45-degree field of view, DR severity per modified Davis staging: 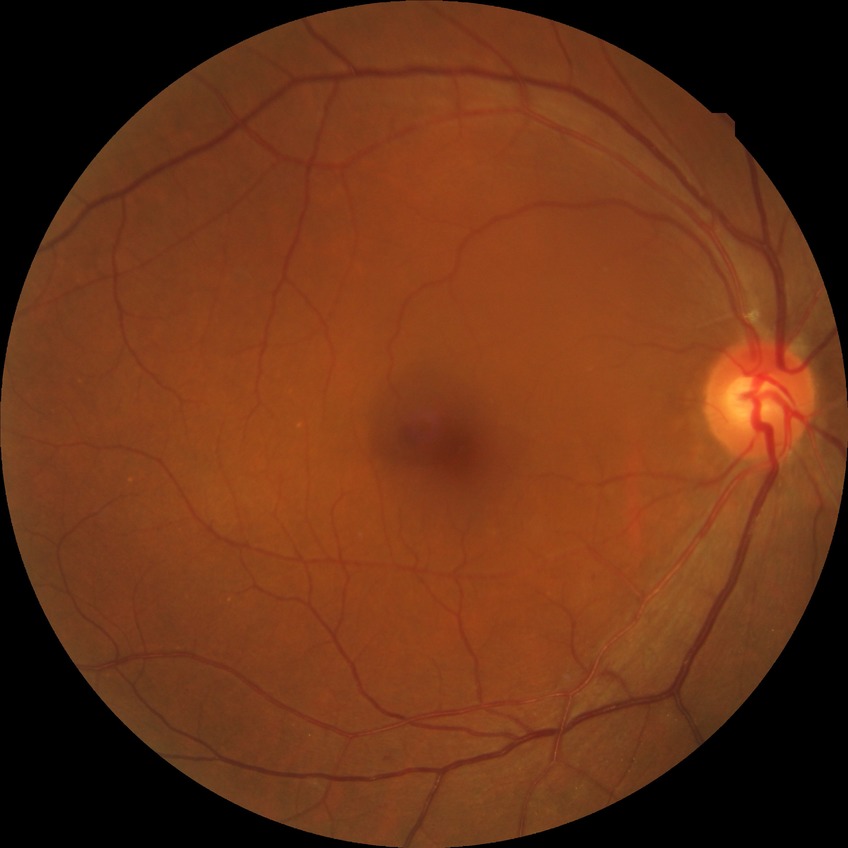
DR grade is NDR.